Color fundus photograph.
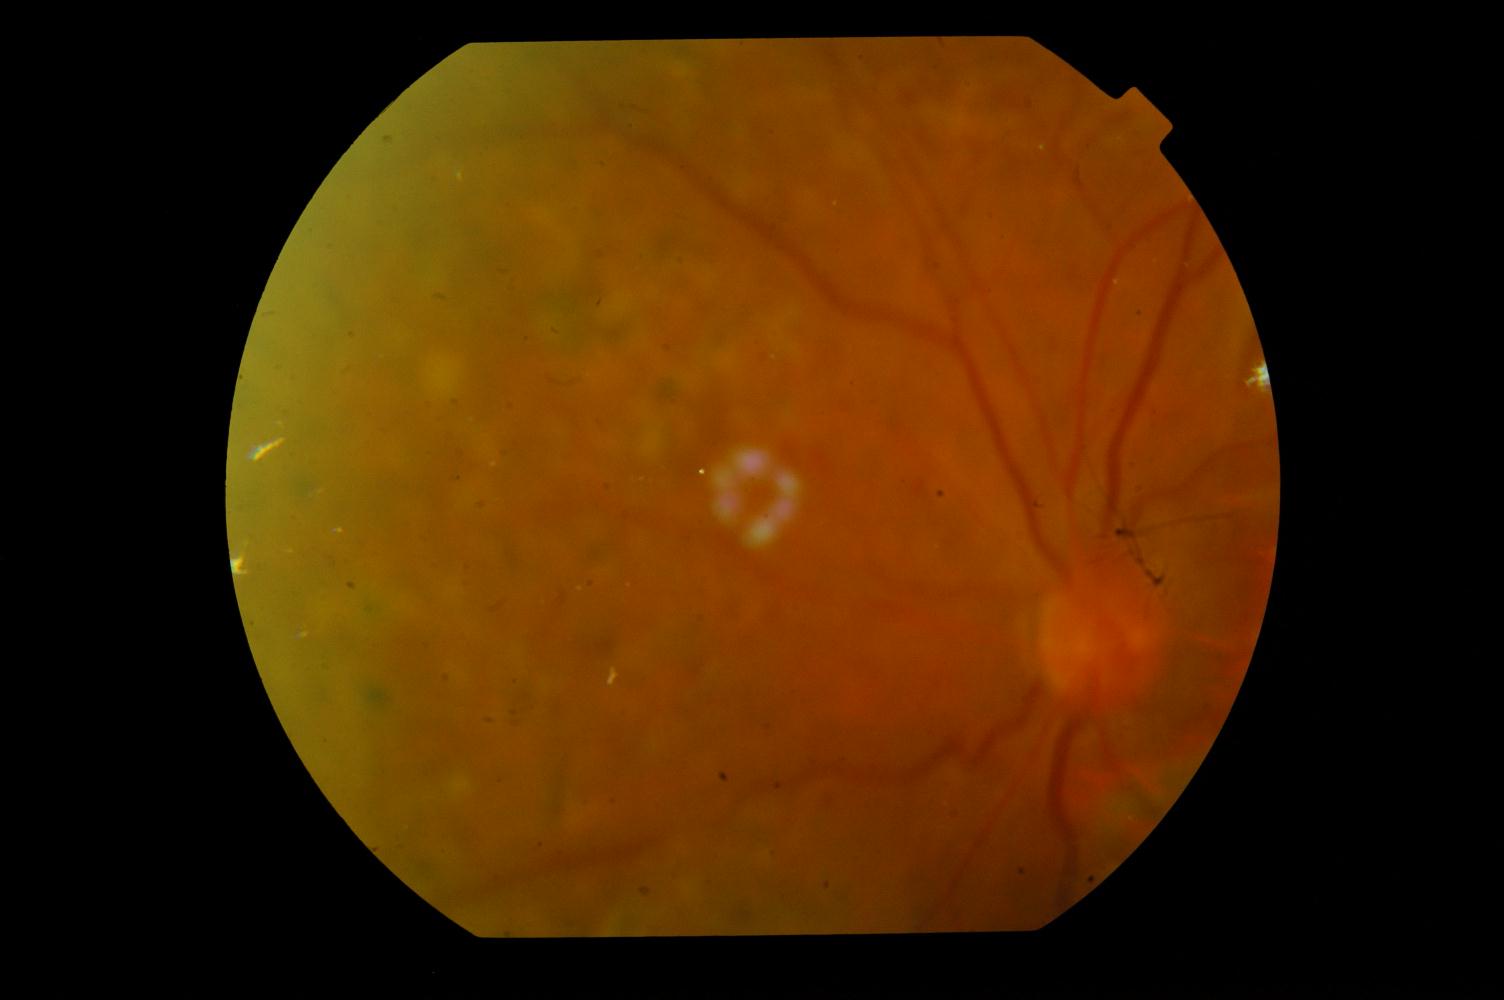
Demonstrates diabetic retinopathy.